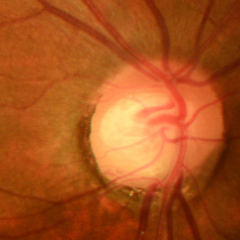

Fundus appearance consistent with early glaucomatous changes. Defined as glaucomatous retinal nerve fiber layer defects on red-free fundus photography without visual field defects.